Without pupil dilation, FOV: 45 degrees.
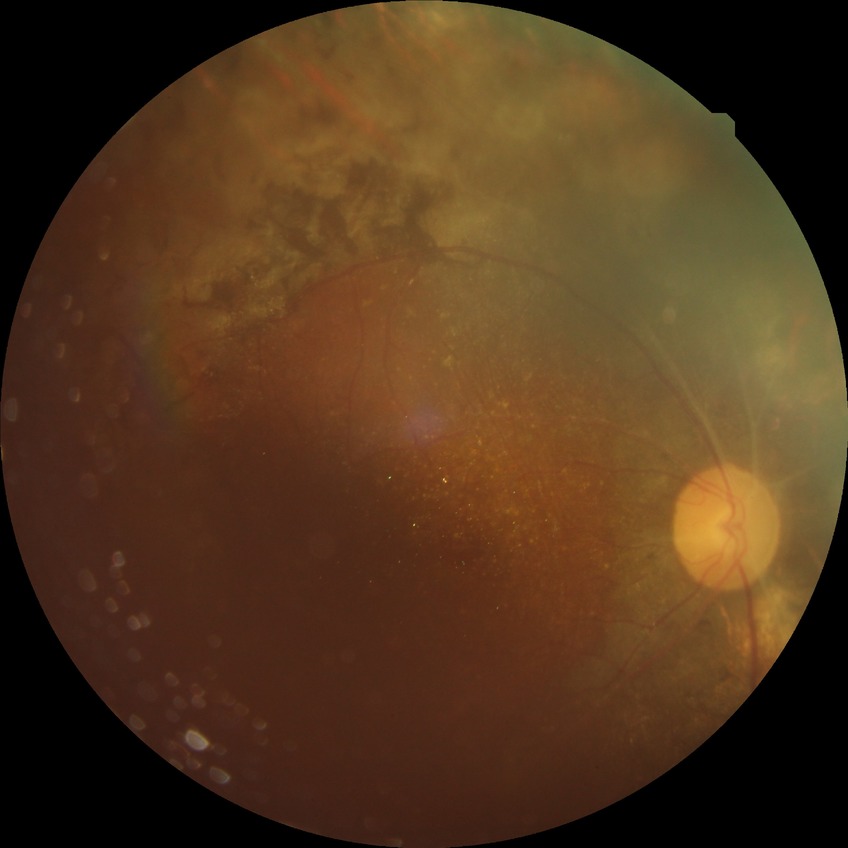

Diabetic retinopathy stage: proliferative diabetic retinopathy.